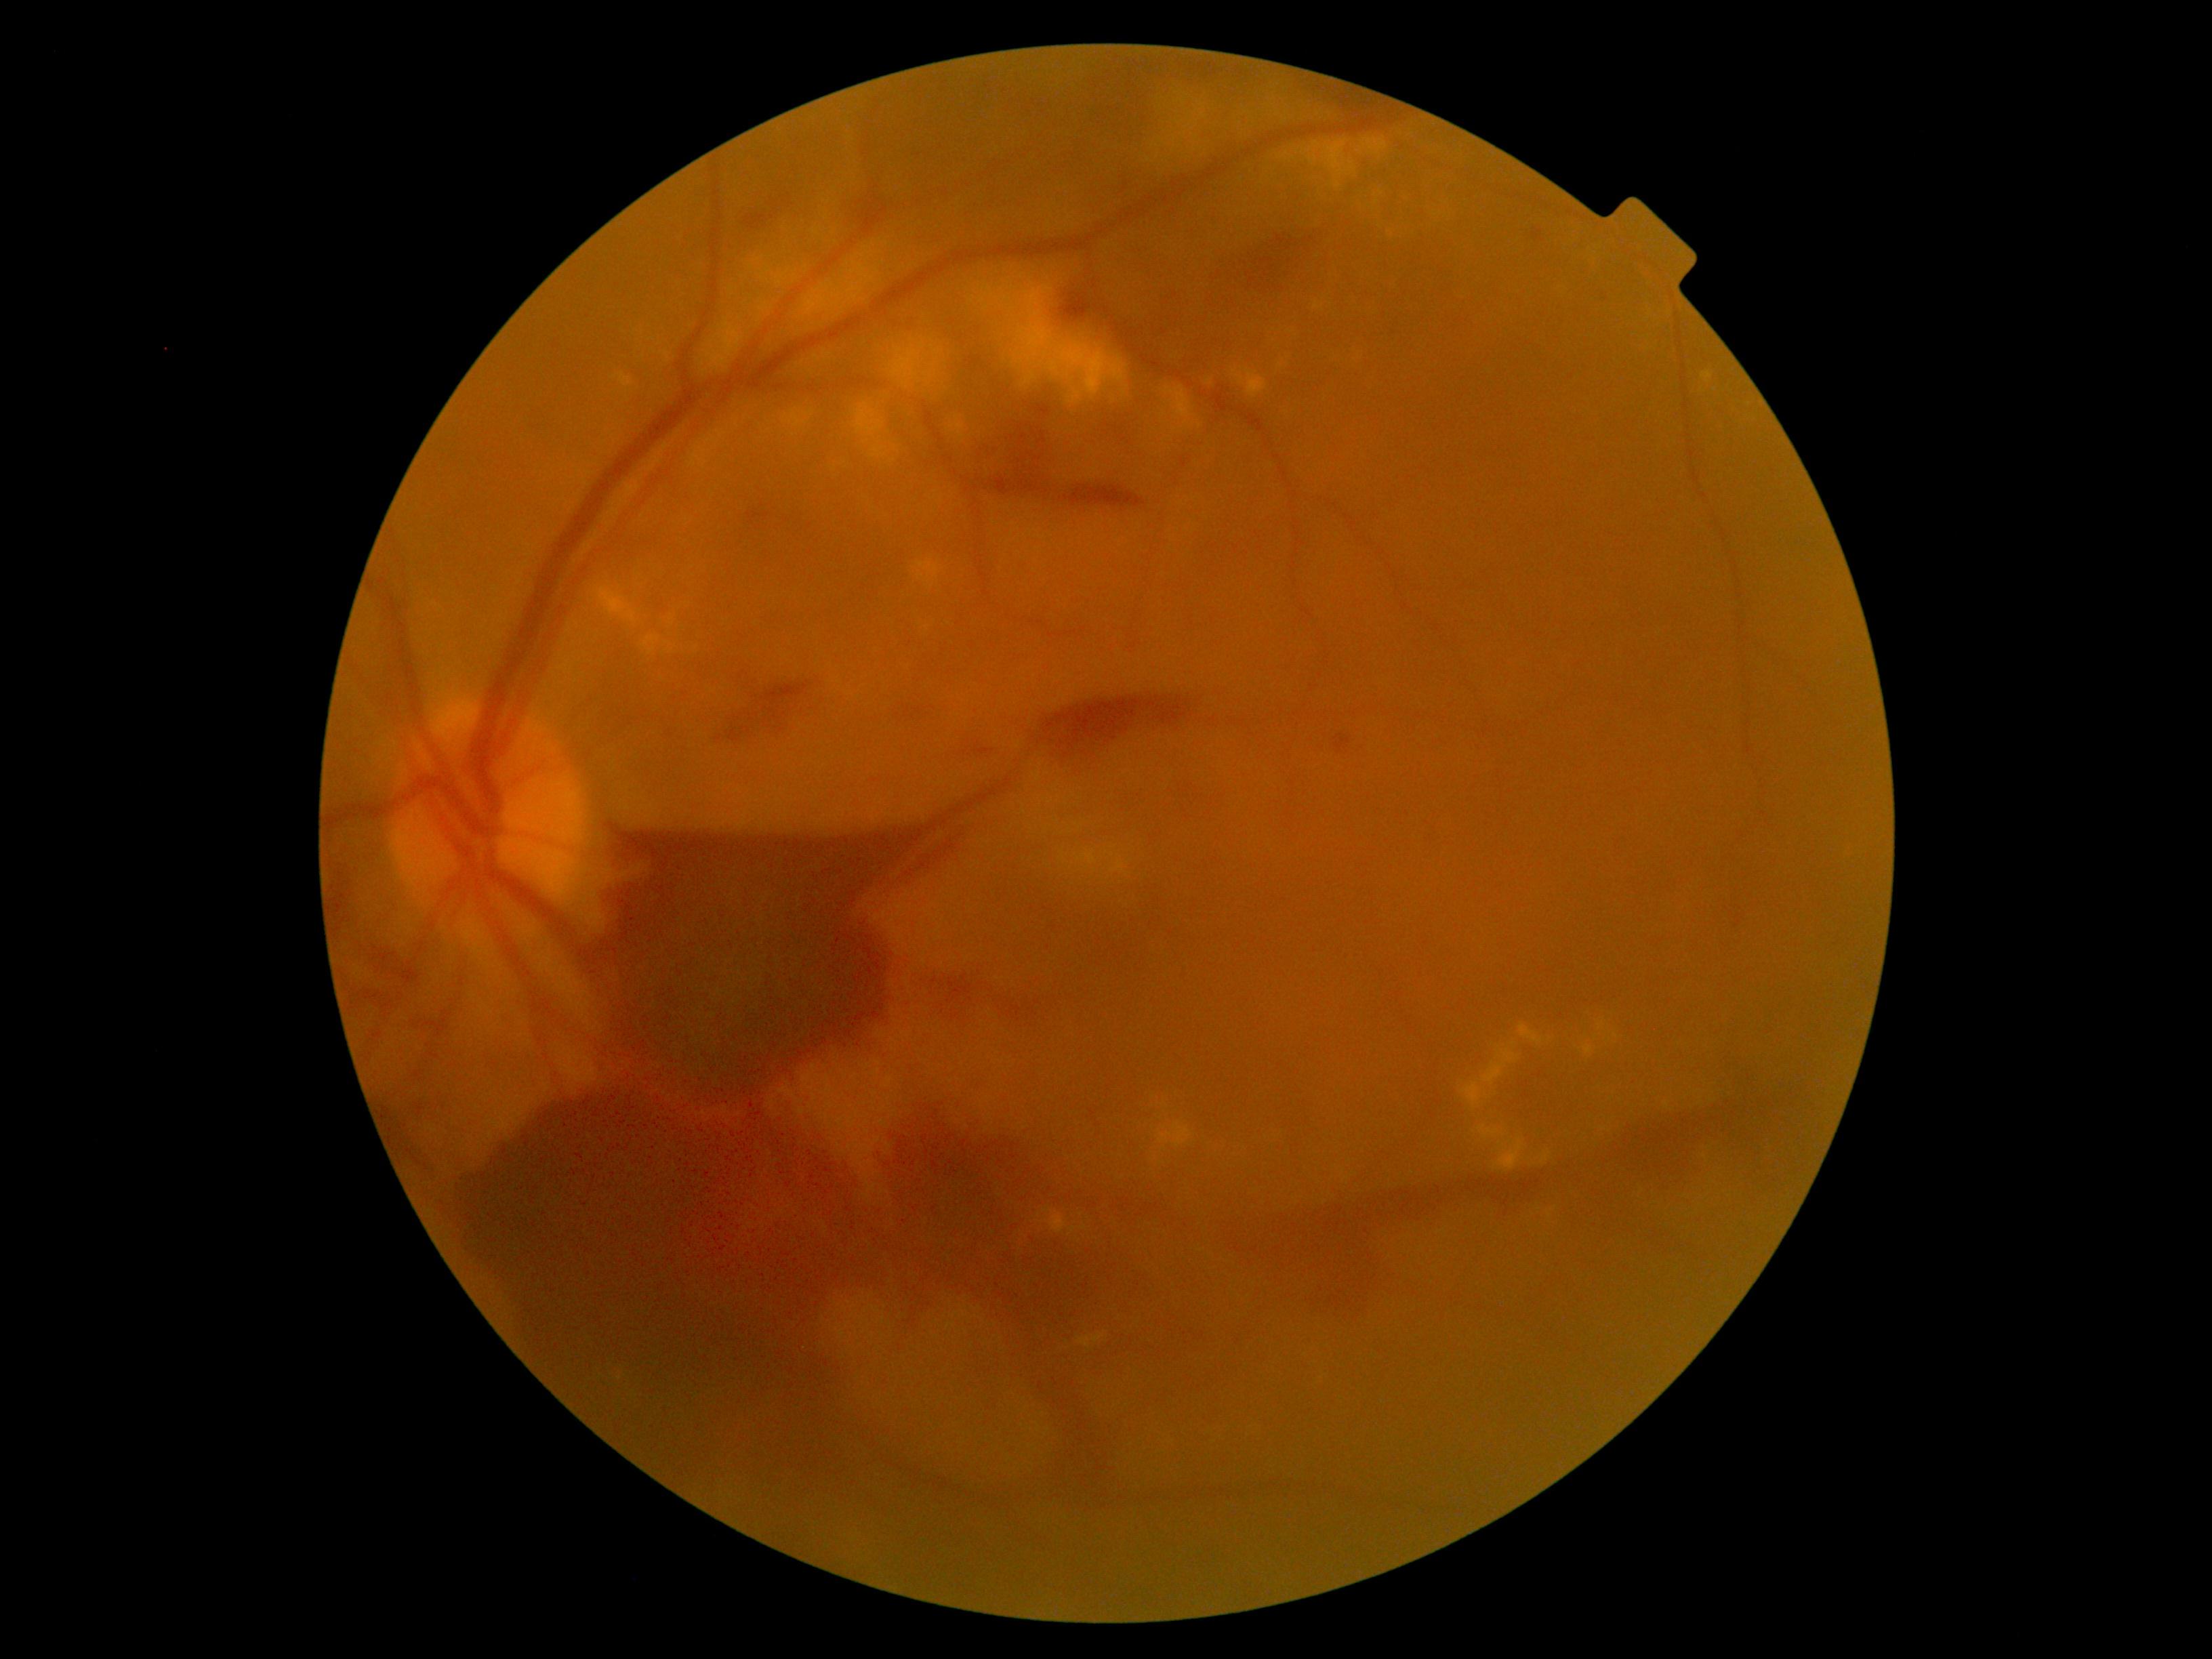 Diabetic retinopathy (DR): 4
A subset of detected lesions:
microaneurysms (MAs) (subset) = 1532,230,1543,241 | 1334,734,1352,754
hemorrhages (HEs) (subset) = 372,949,407,985 | 1142,319,1177,346 | 331,868,353,937 | 987,405,1149,510 | 745,213,769,231 | 747,512,758,523 | 929,982,981,1023 | 894,701,929,720 | 387,1105,428,1174 | 1004,1001,1038,1019 | 1214,223,1337,312 | 453,1090,1820,1614
hard exudates (EXs) (subset) = 1043,1207,1076,1235 | 1360,188,1383,201 | 1399,127,1420,139 | 1478,1126,1505,1141 | 917,562,939,588 | 823,352,833,361 | 1702,372,1714,384 | 1591,254,1603,270 | 853,403,902,463 | 594,586,638,623 | 1568,222,1580,228 | 964,268,1128,407
Small EXs near x=1666, y=1105 | x=669, y=644 | x=665, y=354 | x=759, y=319 | x=610, y=584 | x=1209, y=381
soft exudates (SEs) = none identified